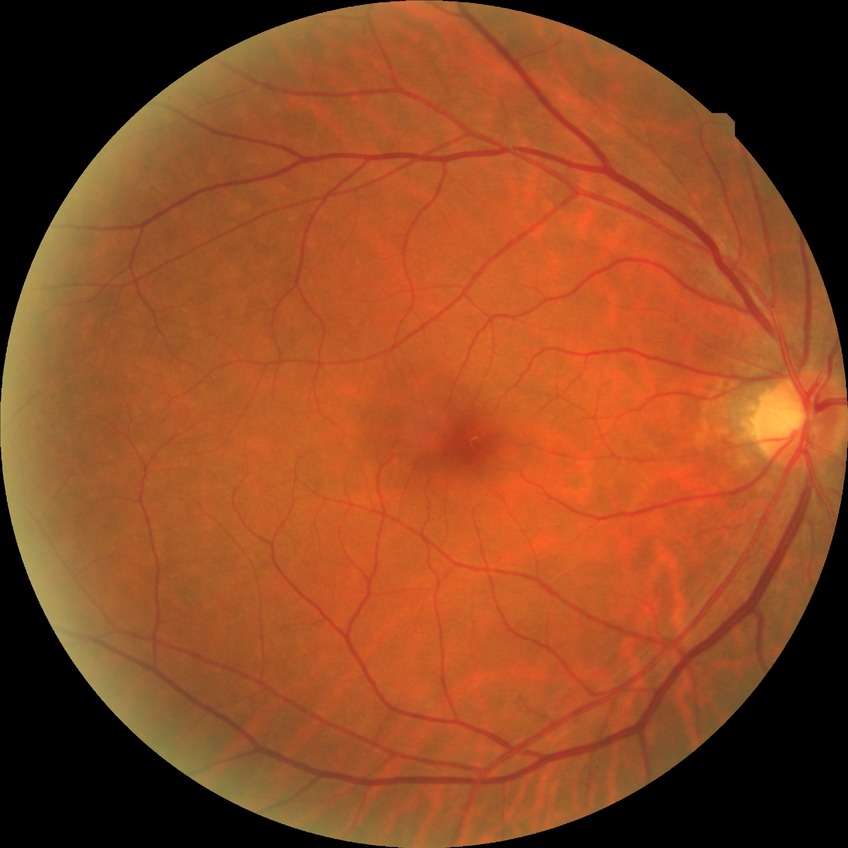 Davis stage: NDR.